Wide-field fundus photograph from neonatal ROP screening:
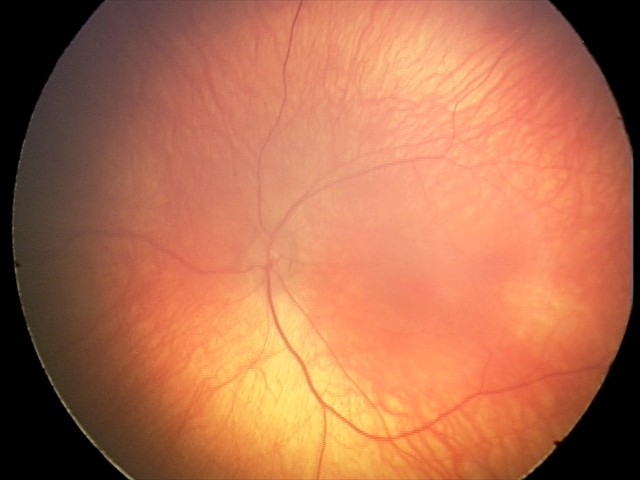

No retinal pathology identified on screening.